Retinal fundus photograph: 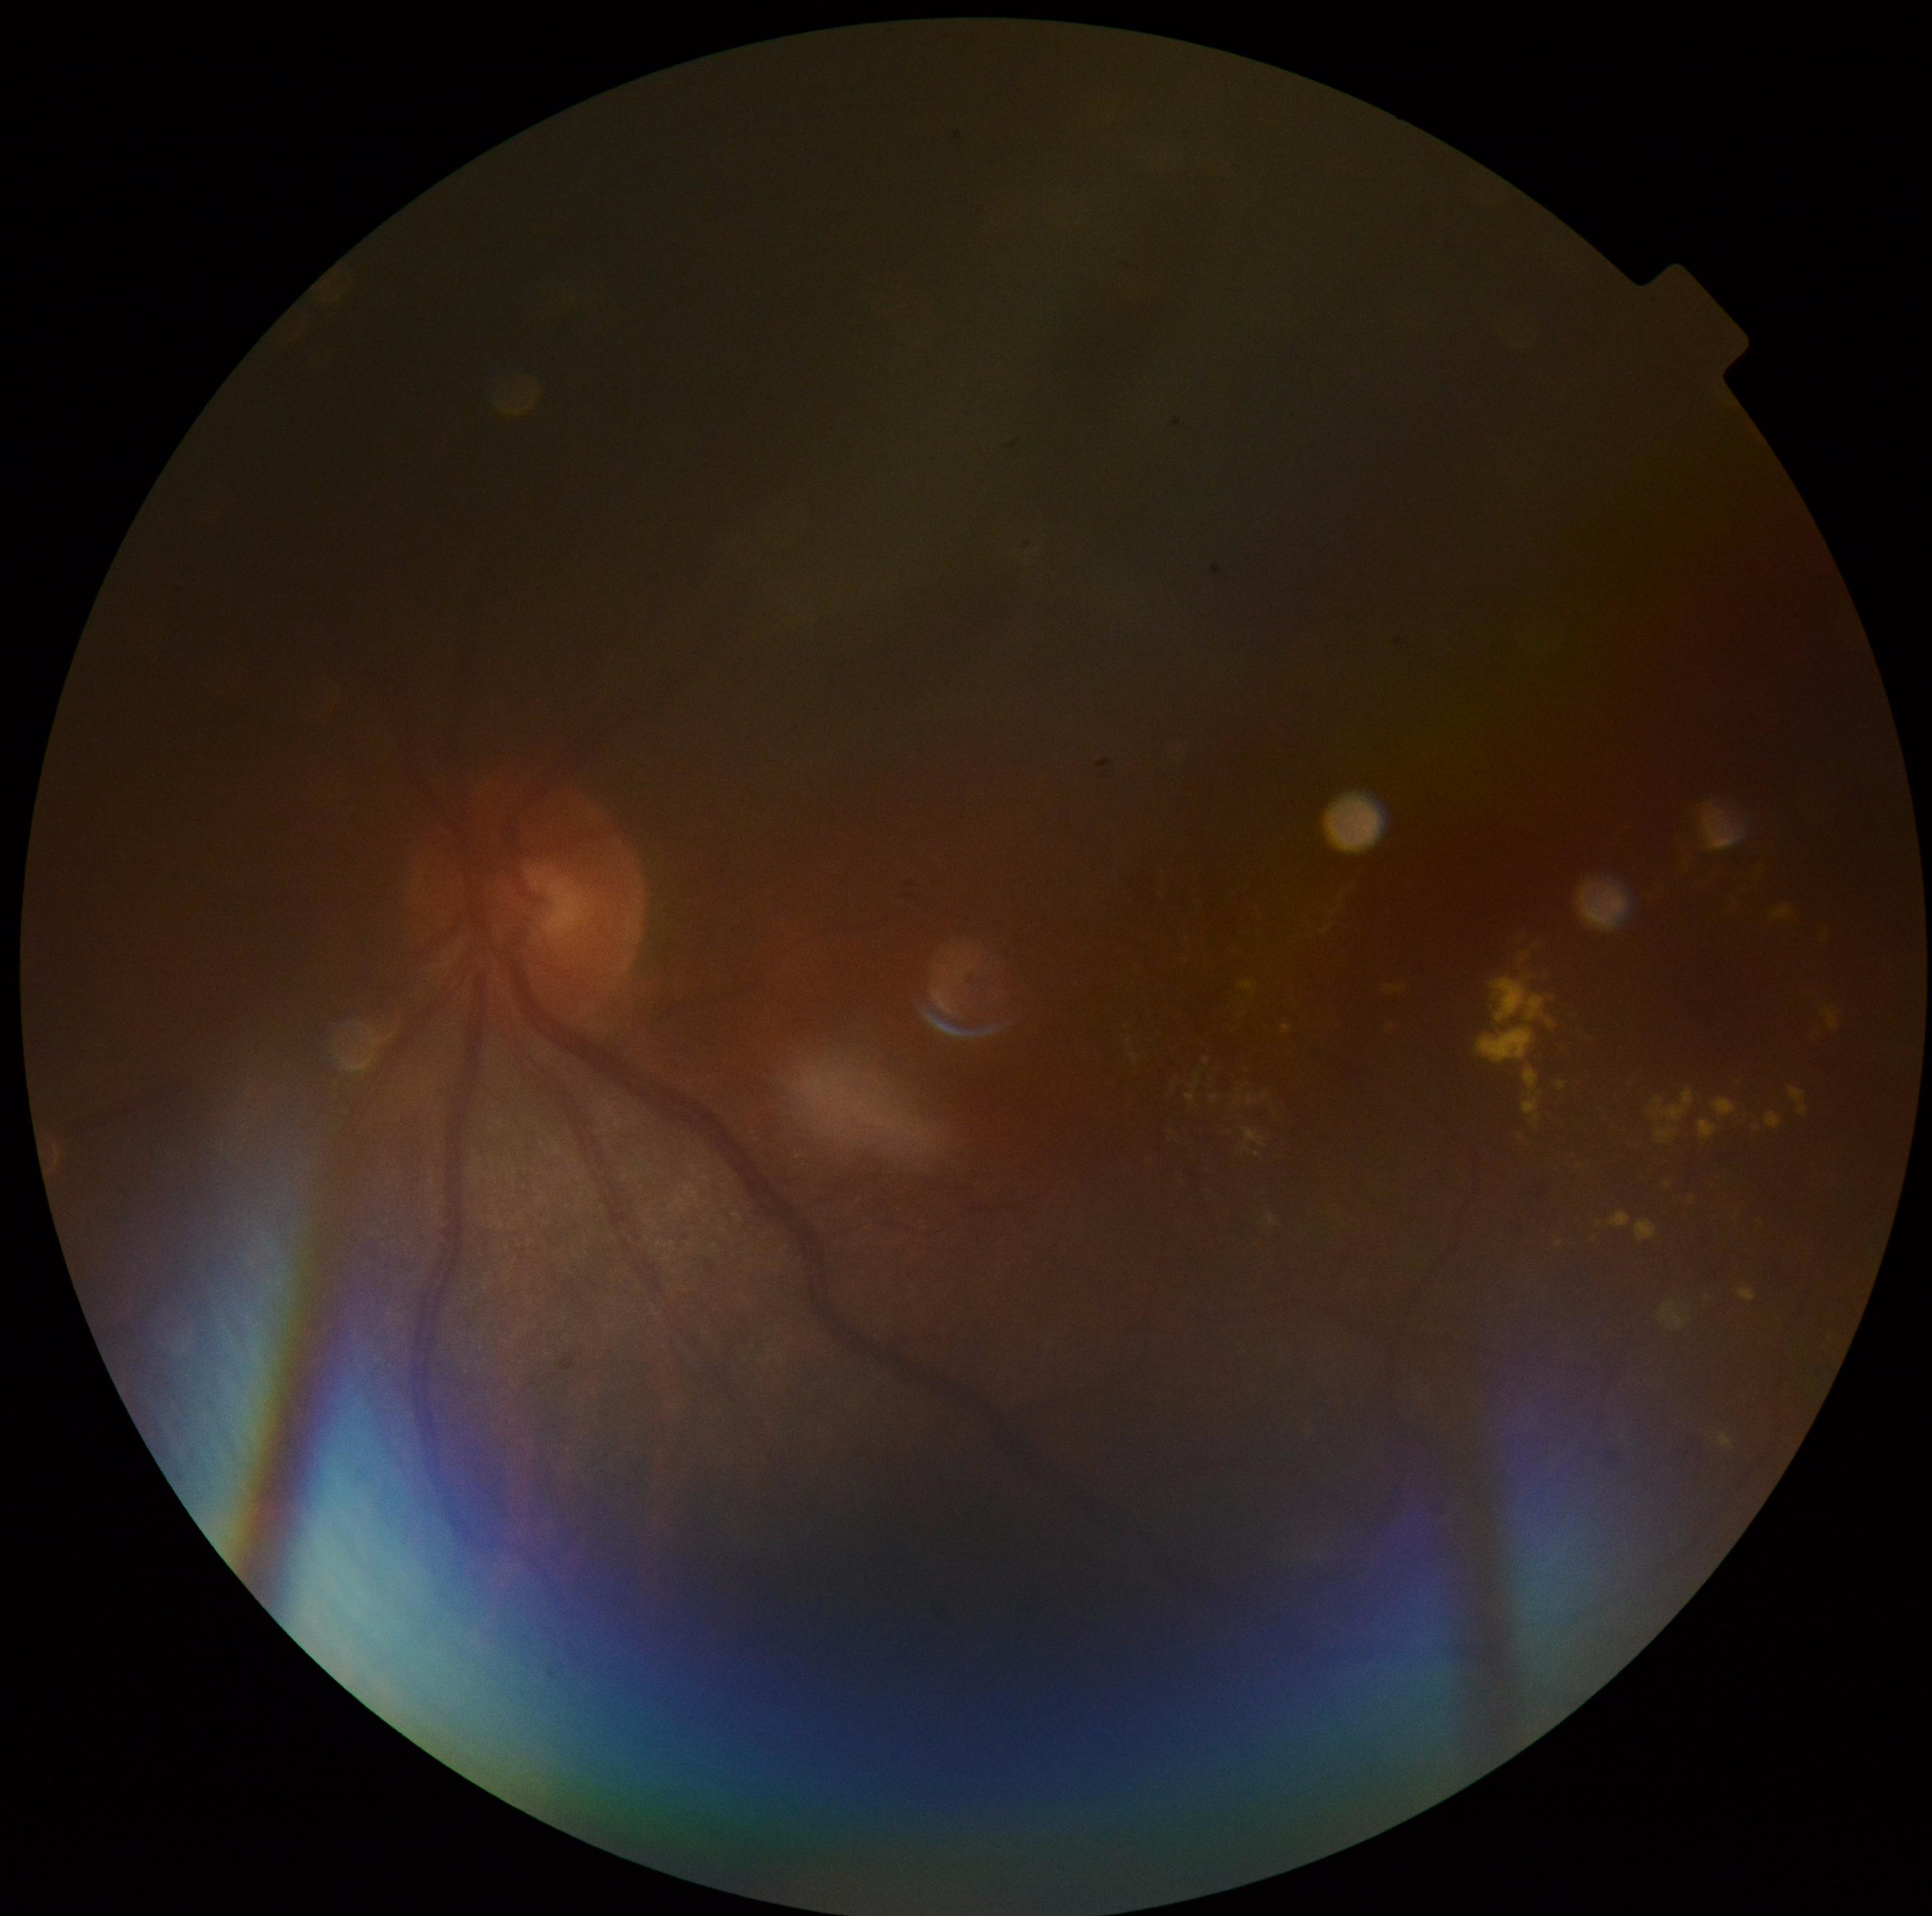 Findings:
* retinopathy grade — 2 (moderate NPDR)
* DR class — non-proliferative diabetic retinopathy